848 by 848 pixels, 45° field of view, graded on the modified Davis scale:
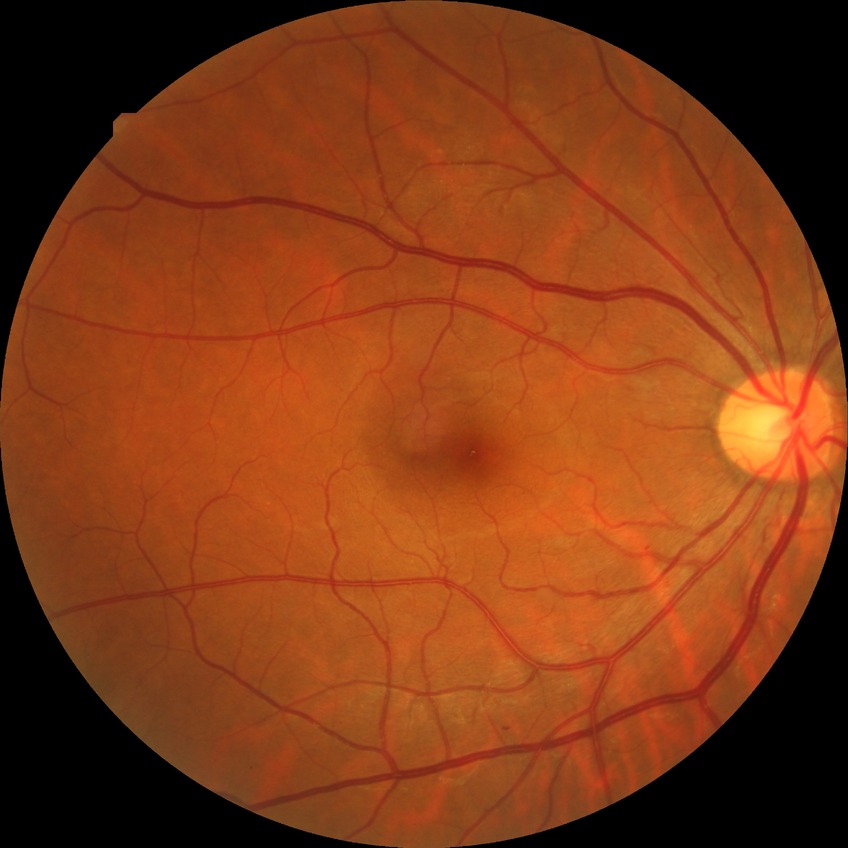
DR stage is SDR.